Intraocular pressure (IOP) 19 mmHg (non-contact tonometry); refraction: sphere -0.5 D, cylinder -1 D, axis 23°; corneal thickness: 577 µm; patient age: 60 years; non-mydriatic acquisition — 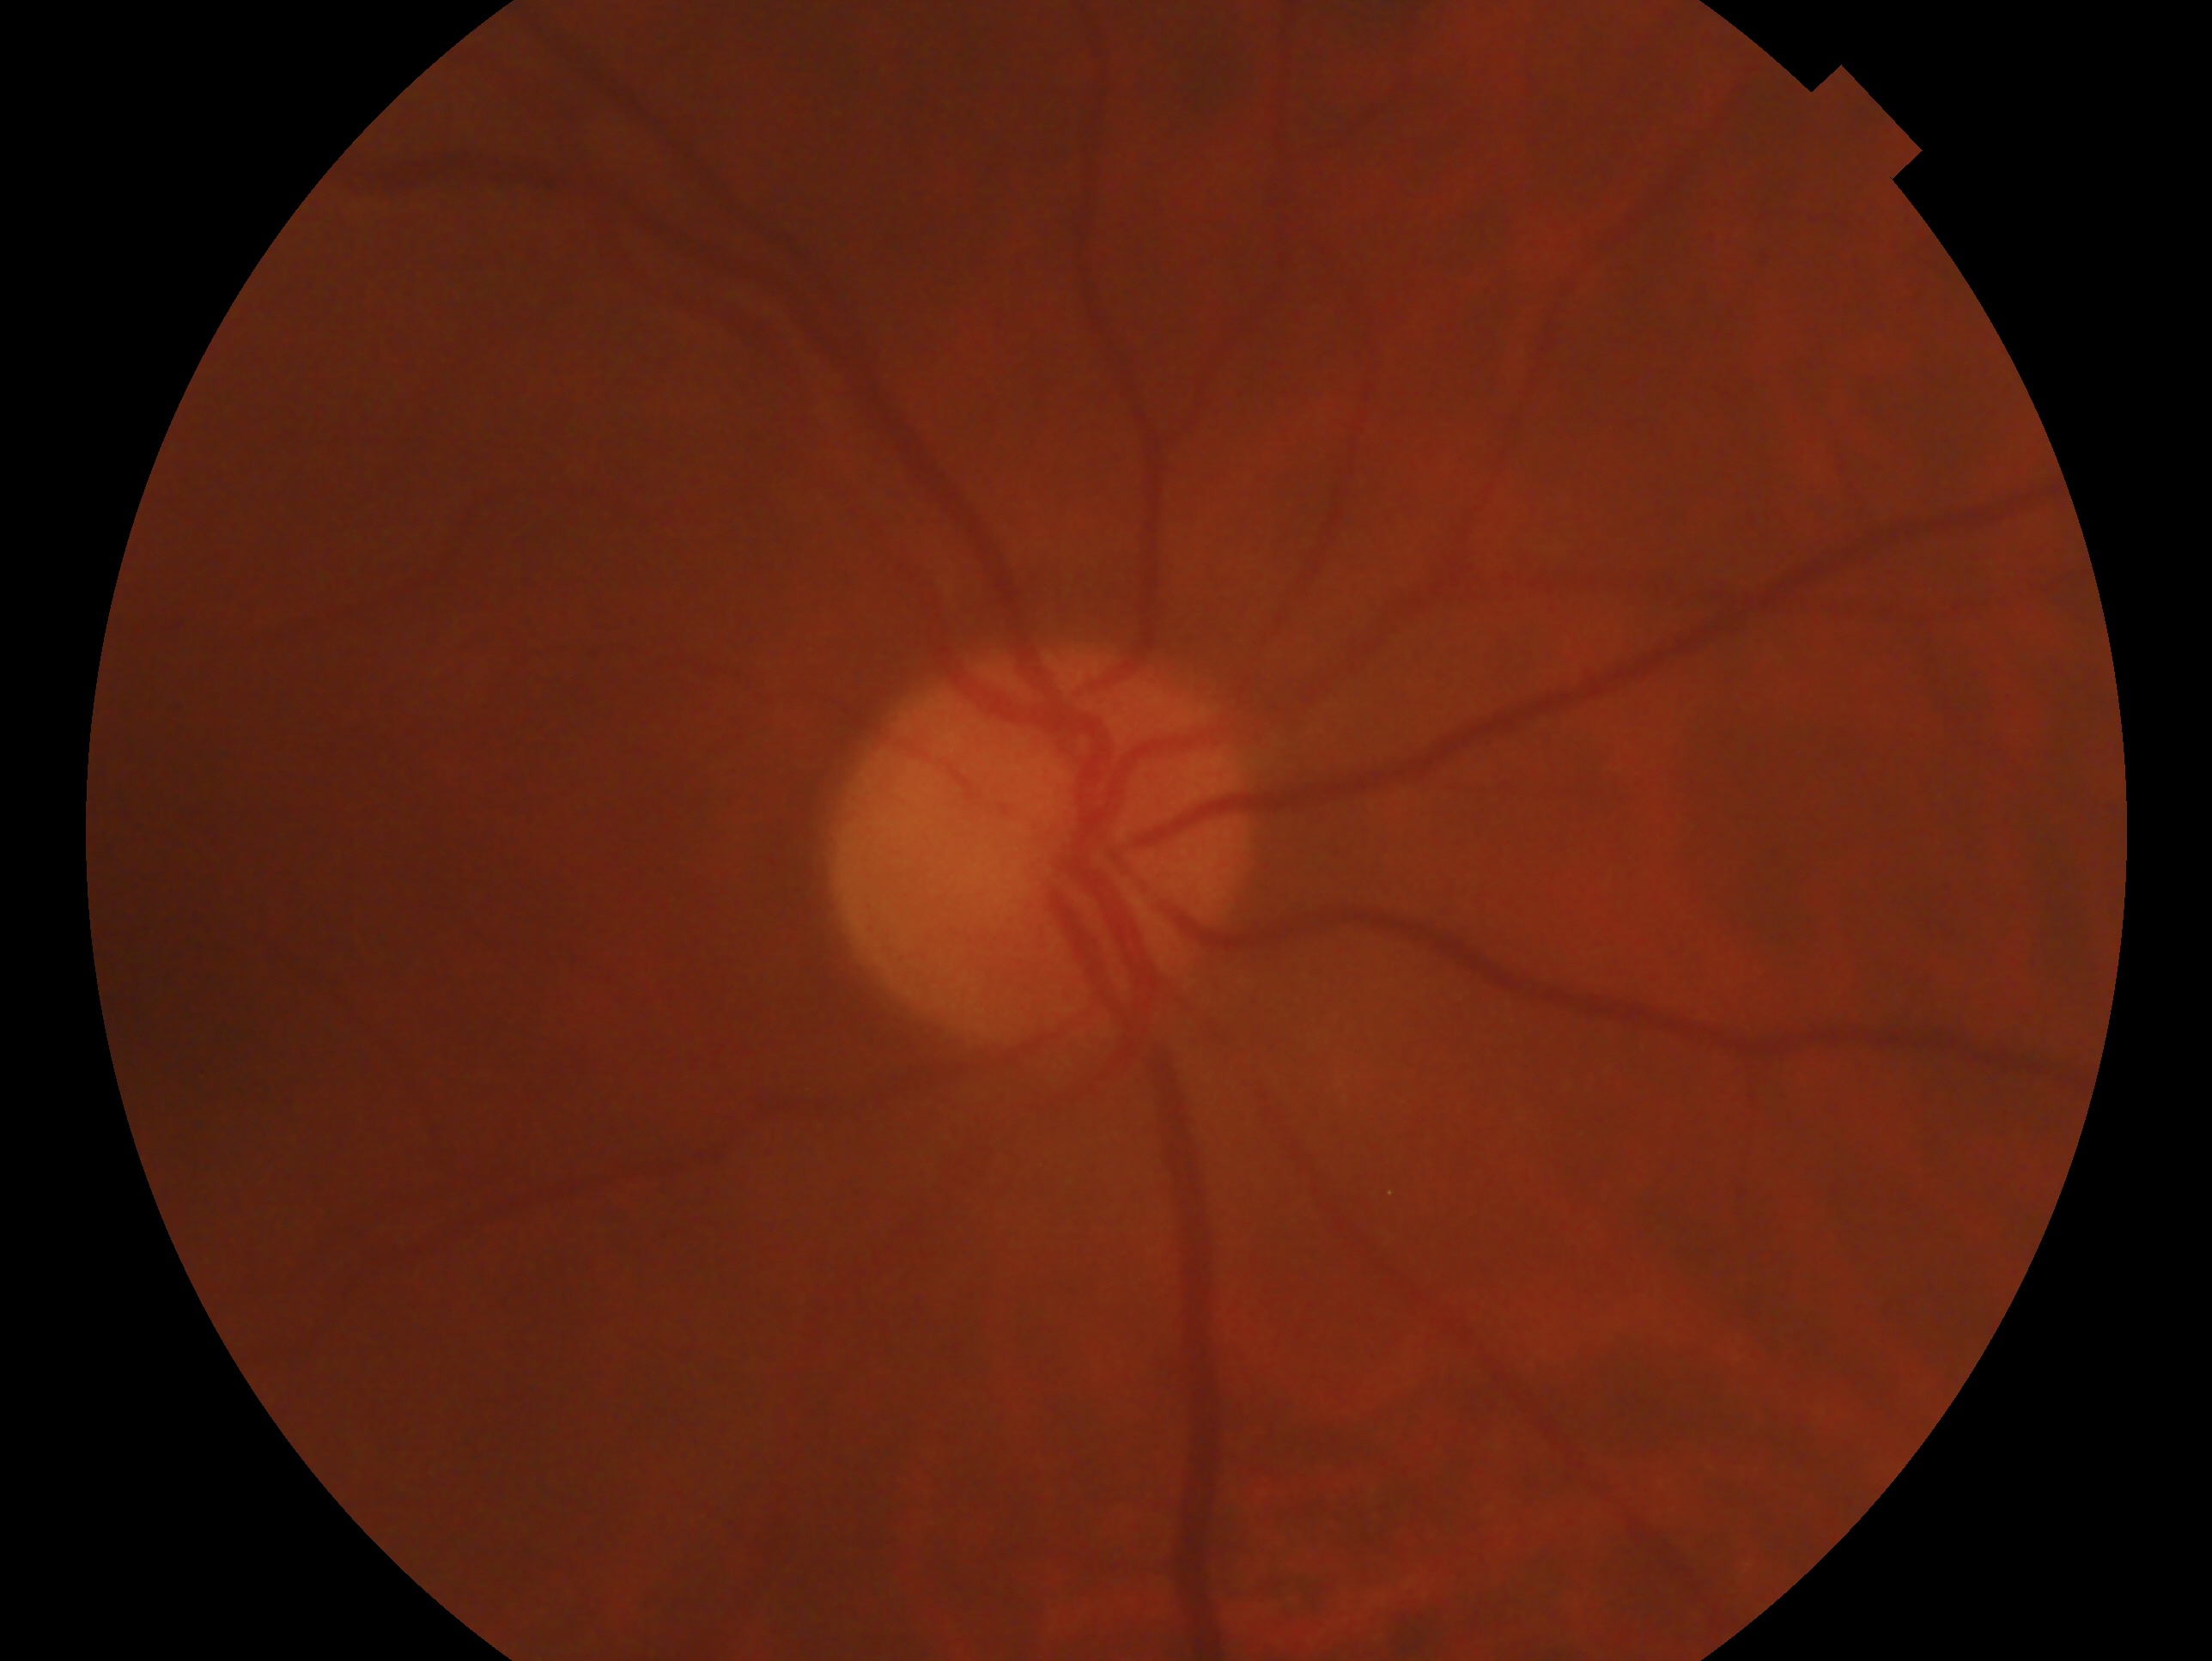

diagnosis: no glaucomatous findings | eye: OD.